Optic disc region of a color fundus photo
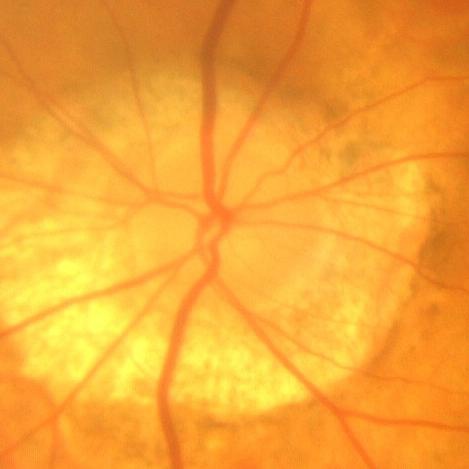

Findings consistent with no signs of glaucoma.